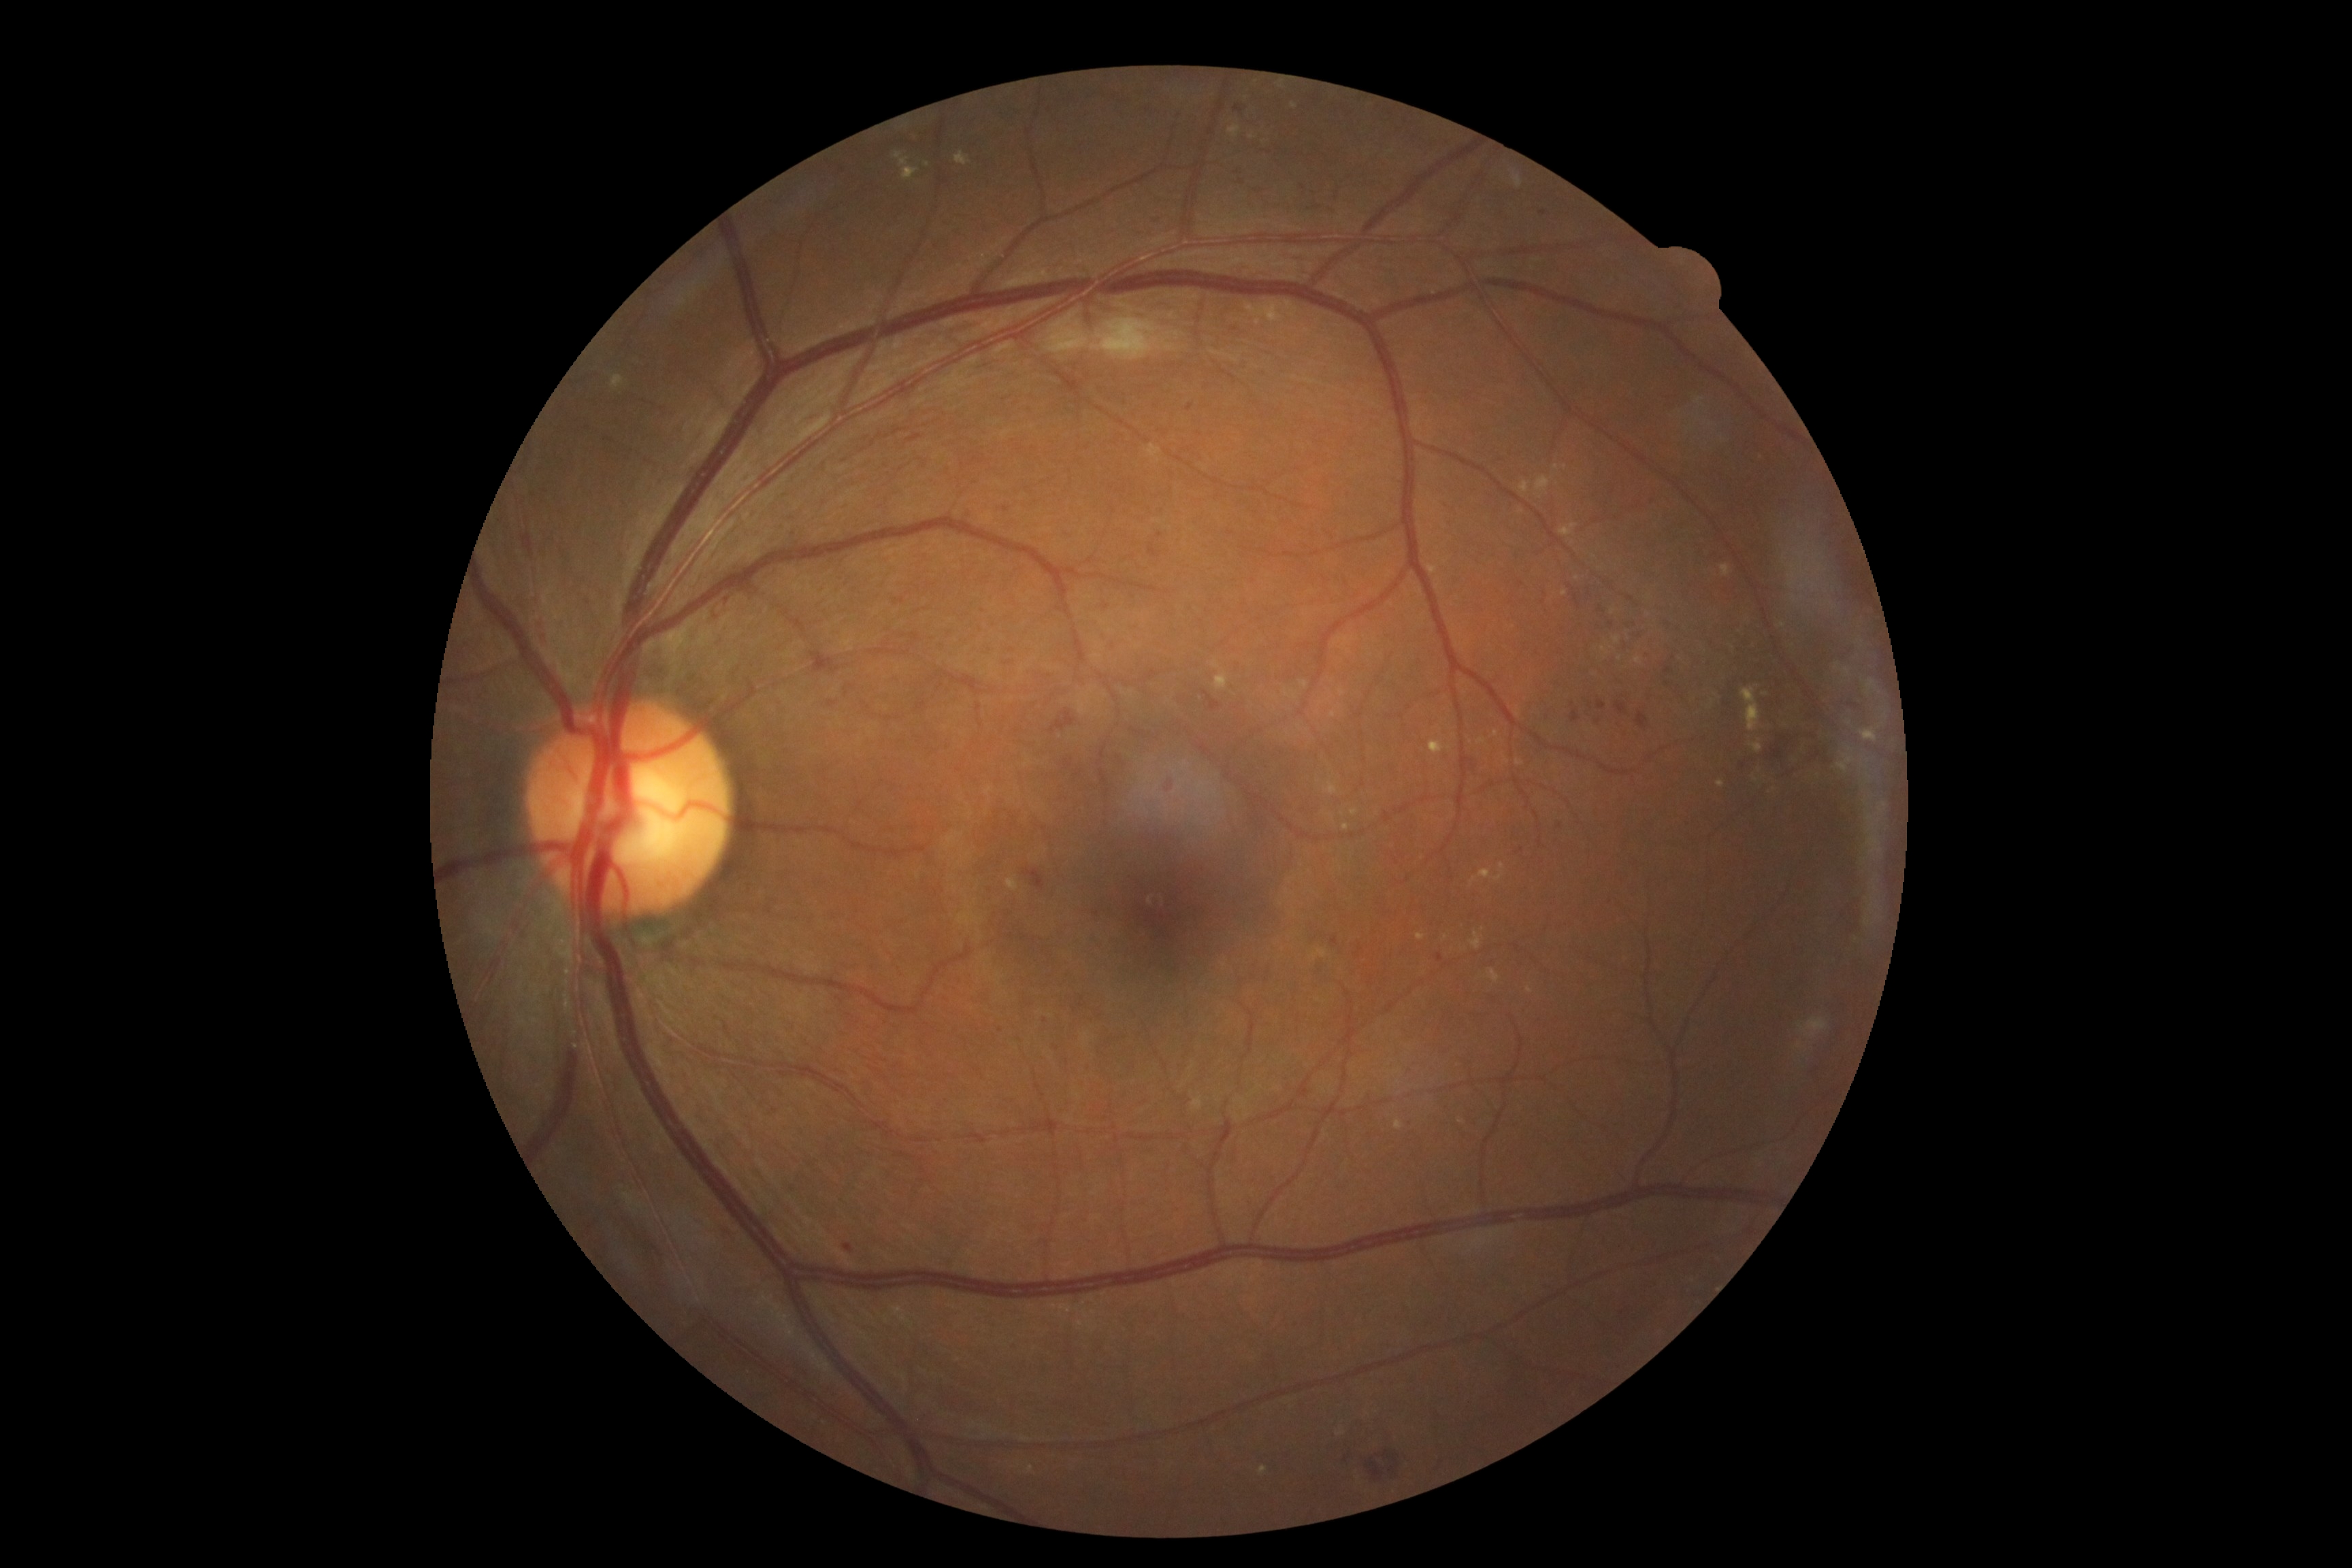
diabetic retinopathy (DR)@2 — more than just microaneurysms but less than severe NPDR.